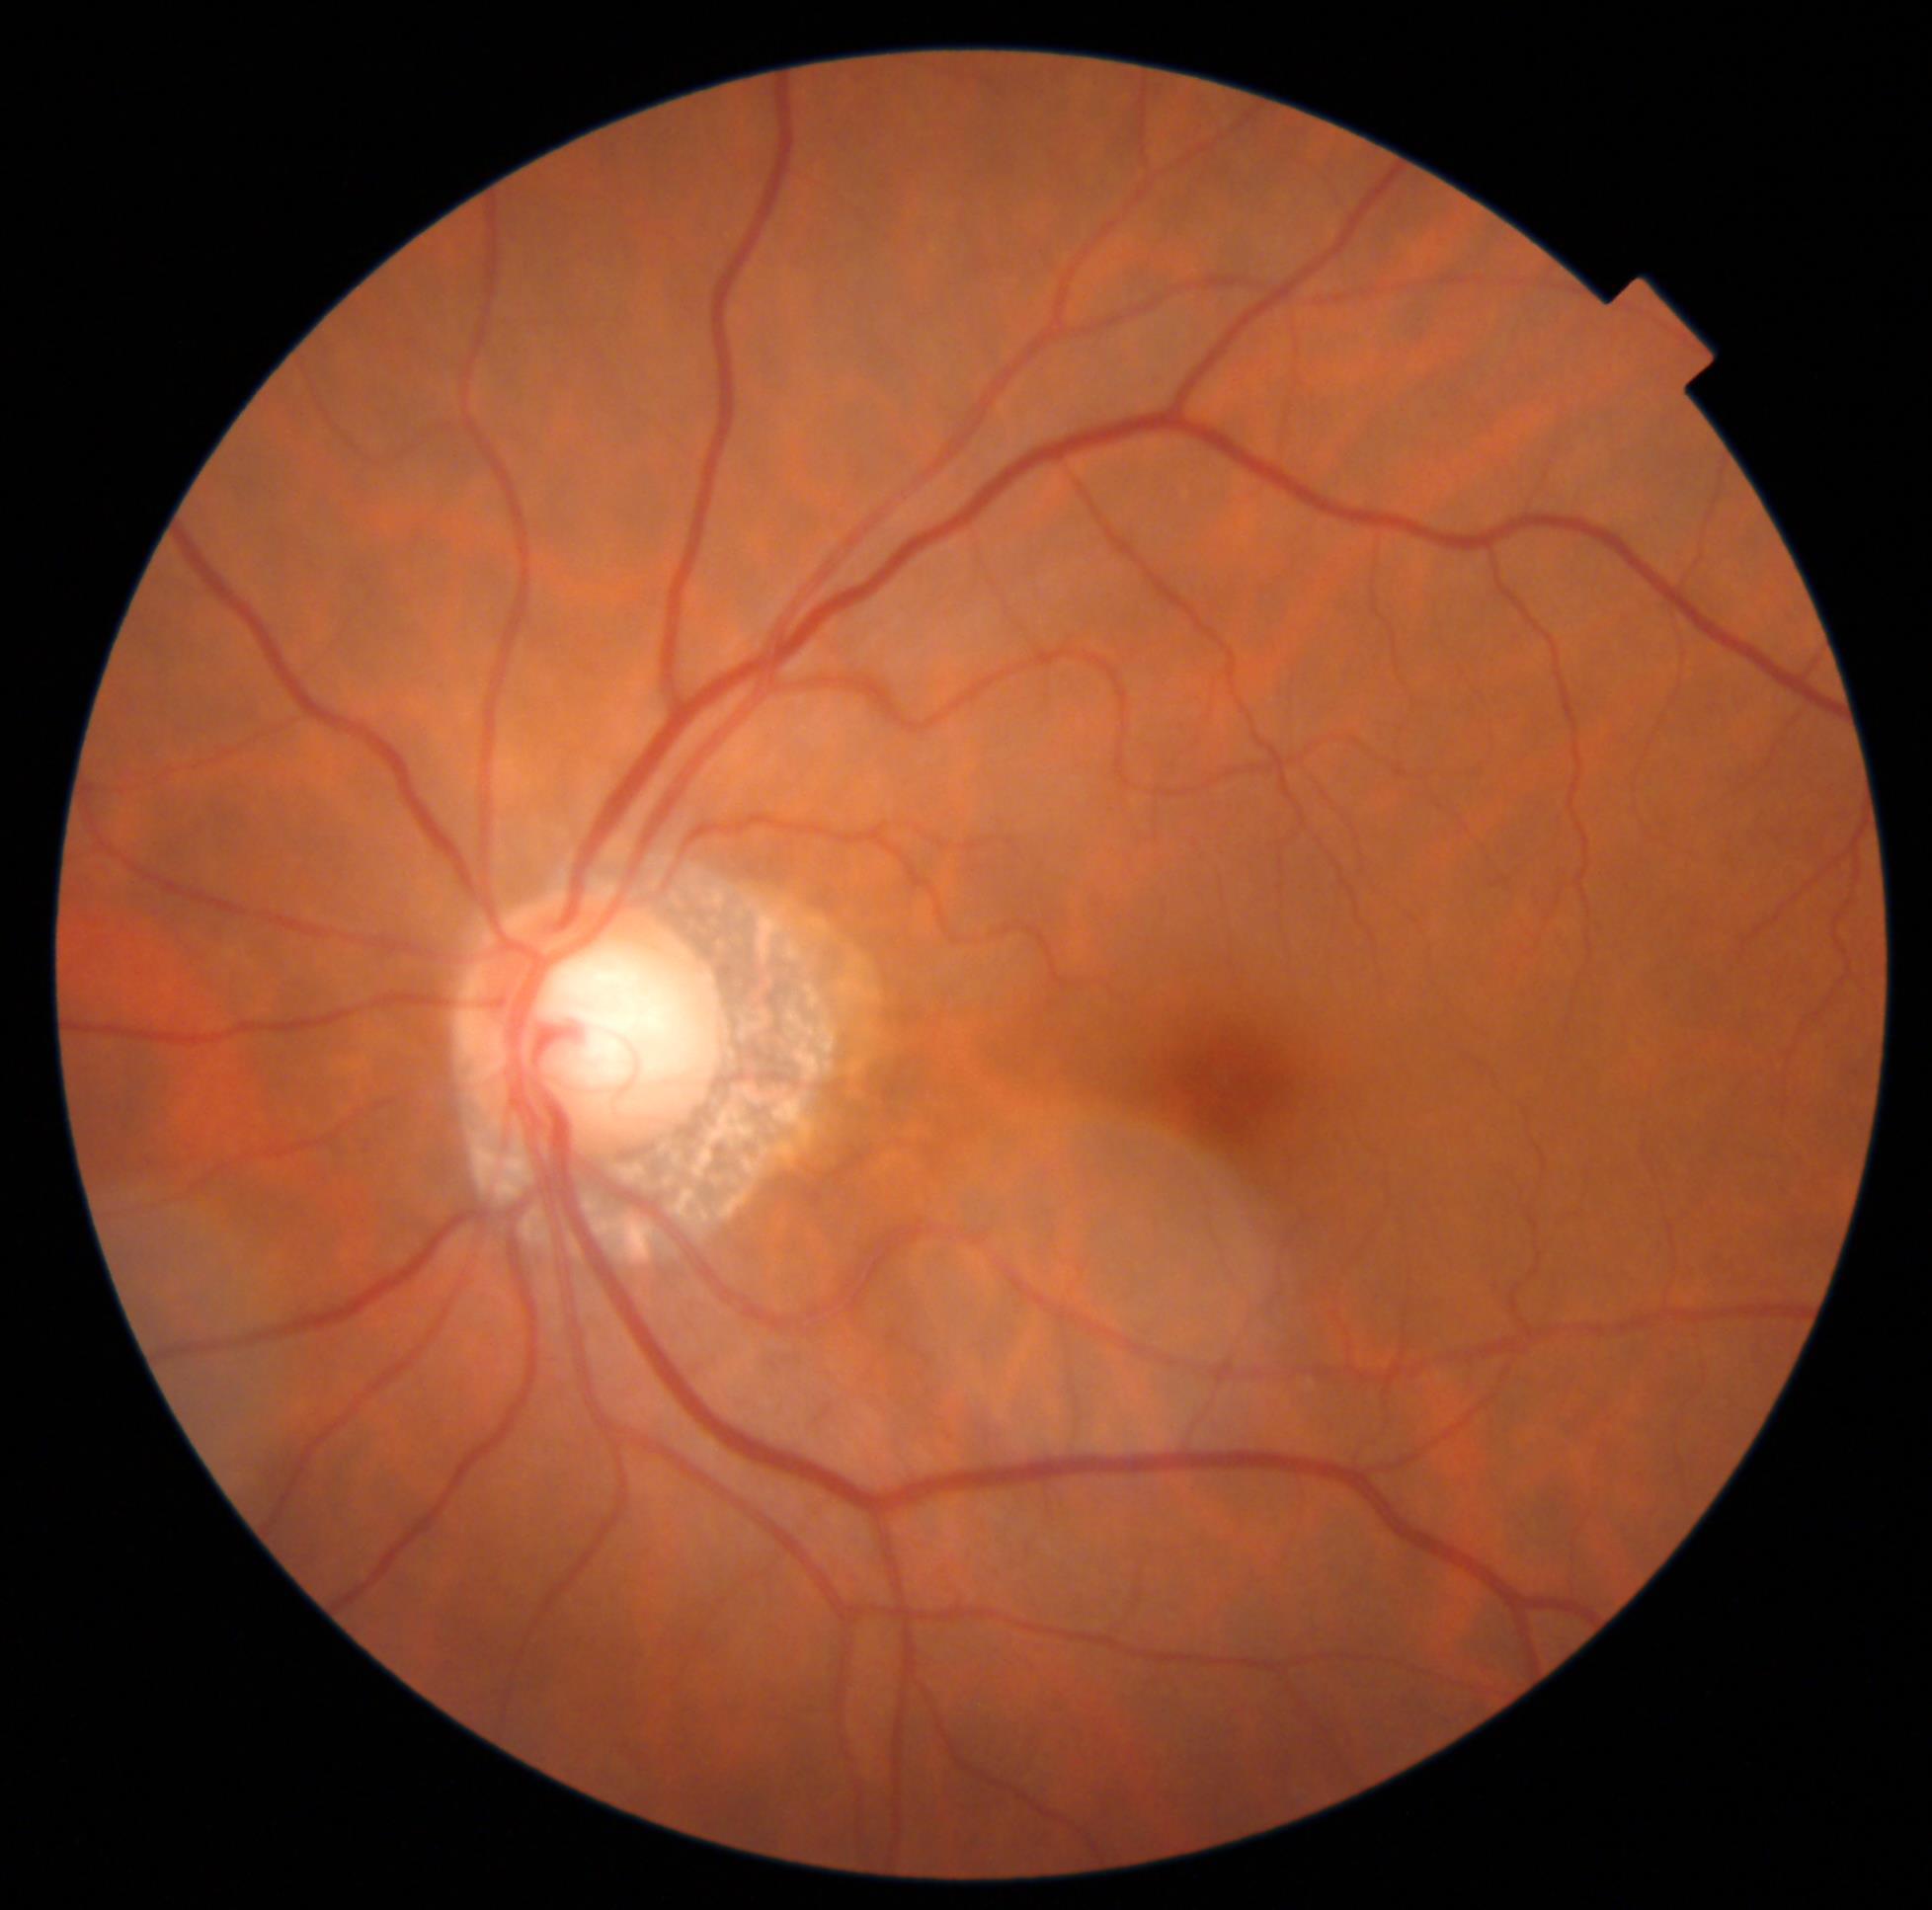
DR impression=no signs of DR; DR grade=0.